NIDEK AFC-230 fundus camera:
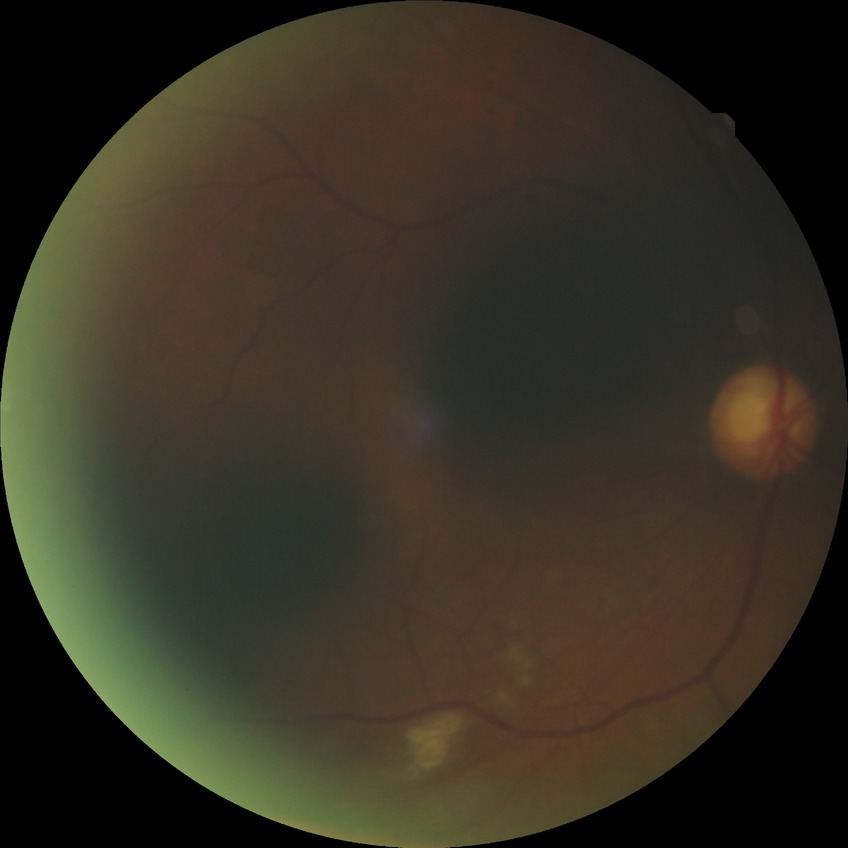 retinopathy stage: pre-proliferative diabetic retinopathy.